Fundus image cropped to the optic disc: 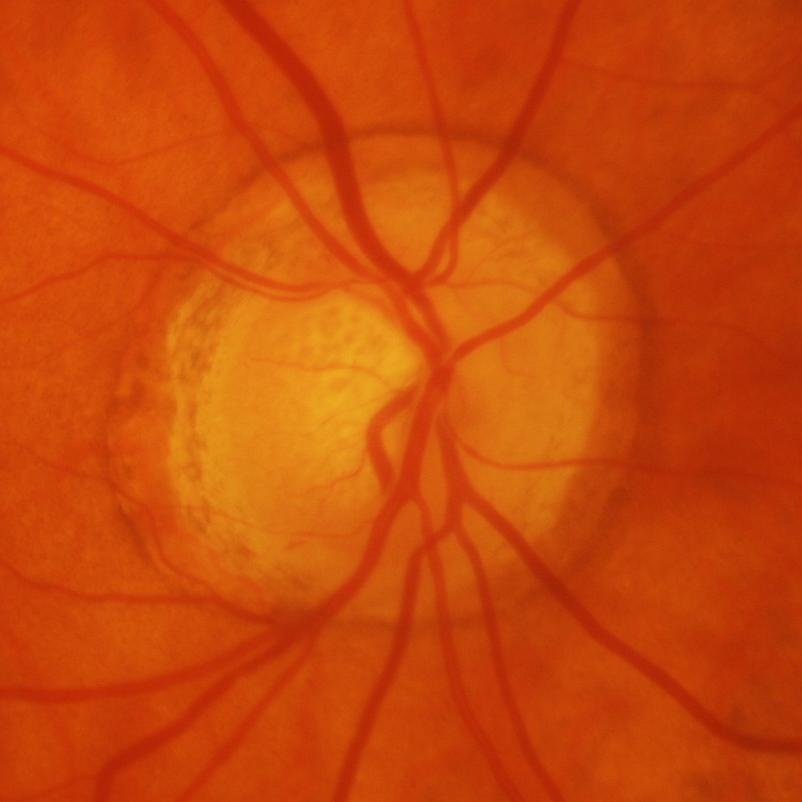

Q: Is there glaucomatous optic neuropathy?
A: Yes — glaucomatous changes.